45 degree fundus photograph · modified Davis classification: 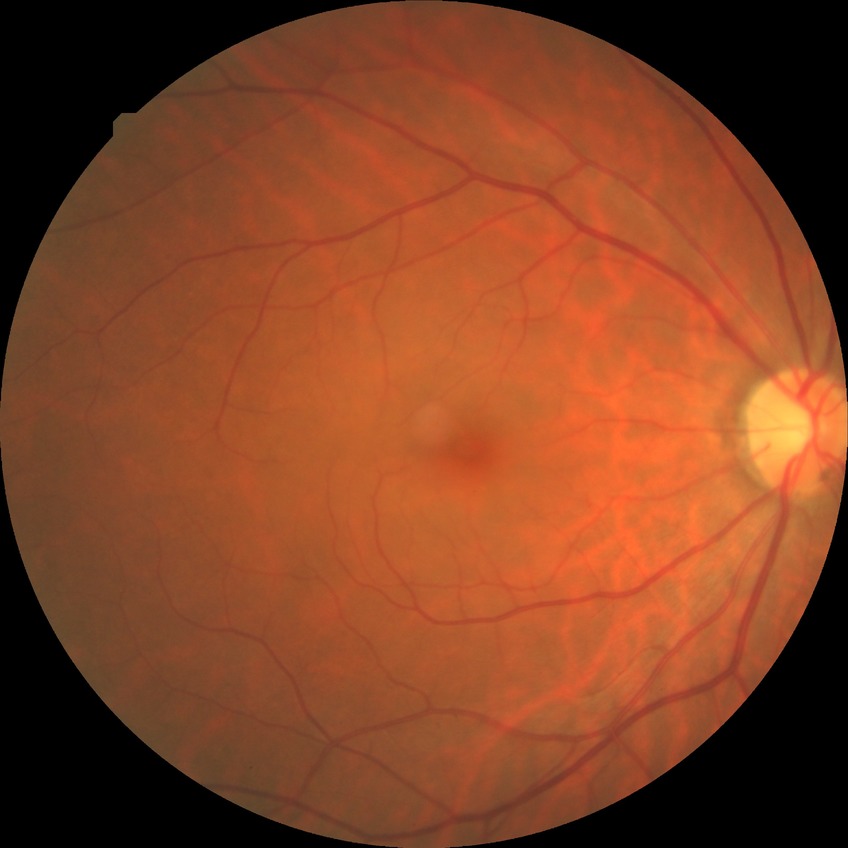
Diabetic retinopathy grade is no diabetic retinopathy.